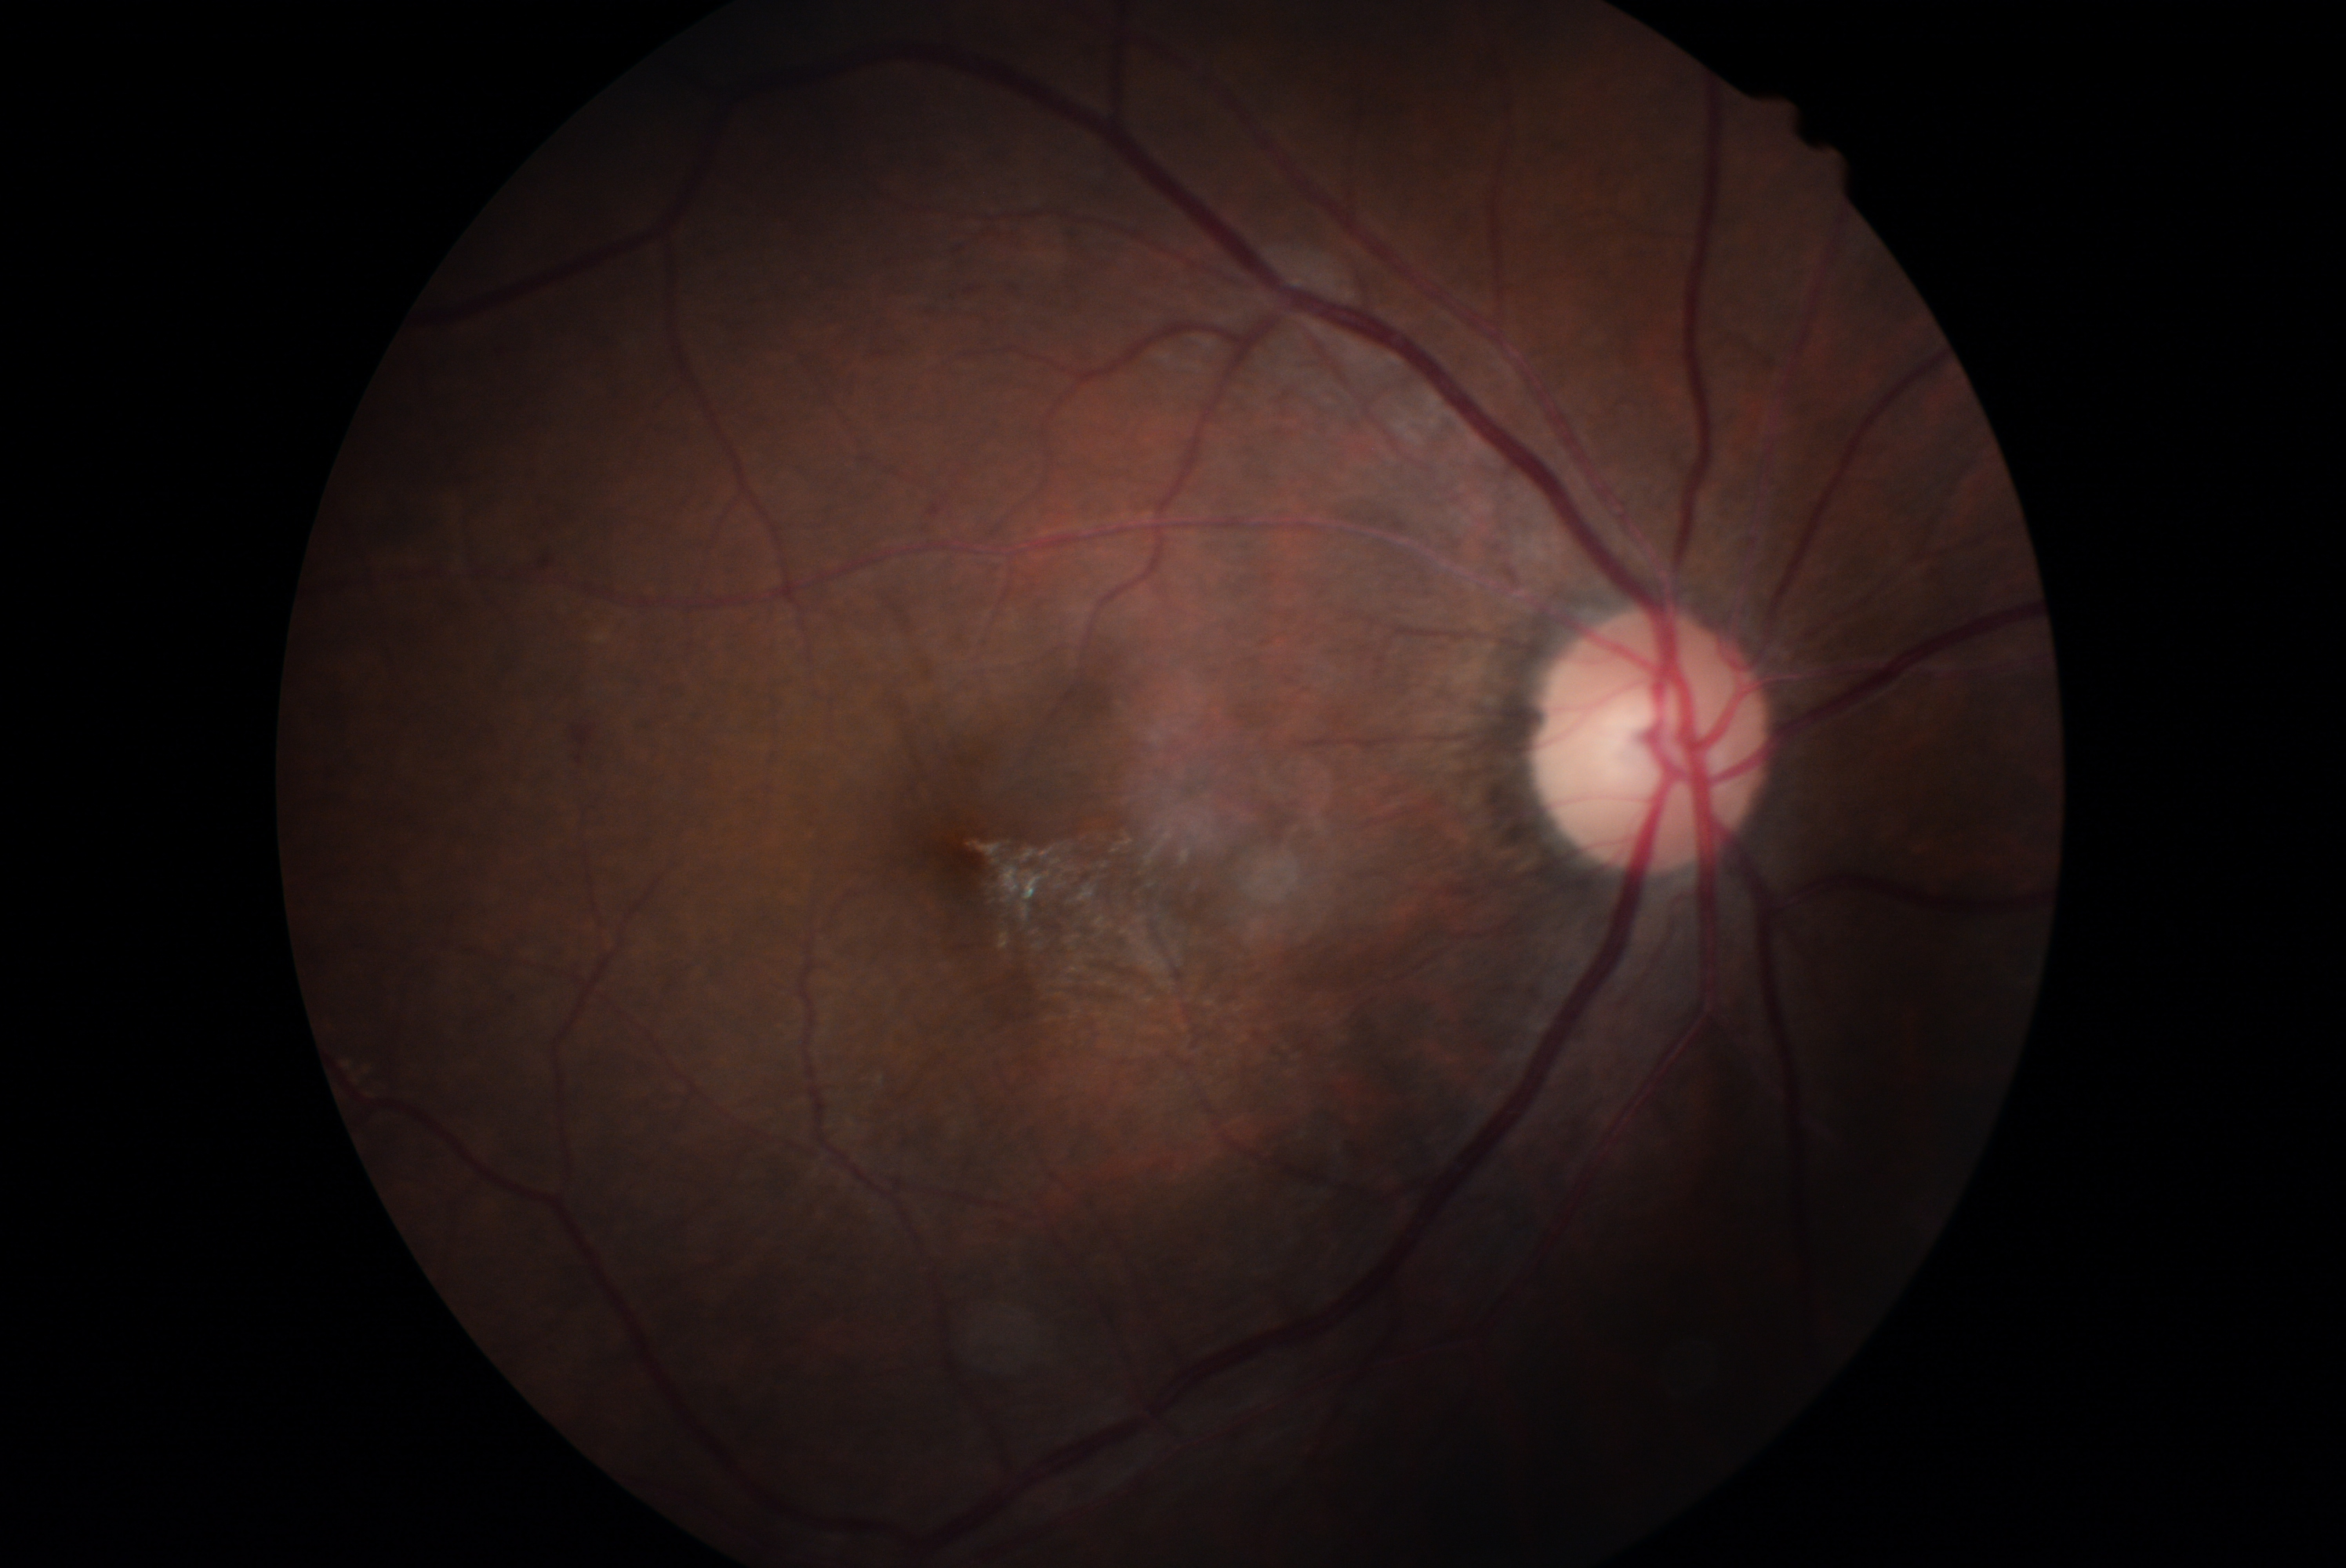

Findings:
– DR: grade 2 (moderate NPDR)